Image size 1960x1897, 45° field of view
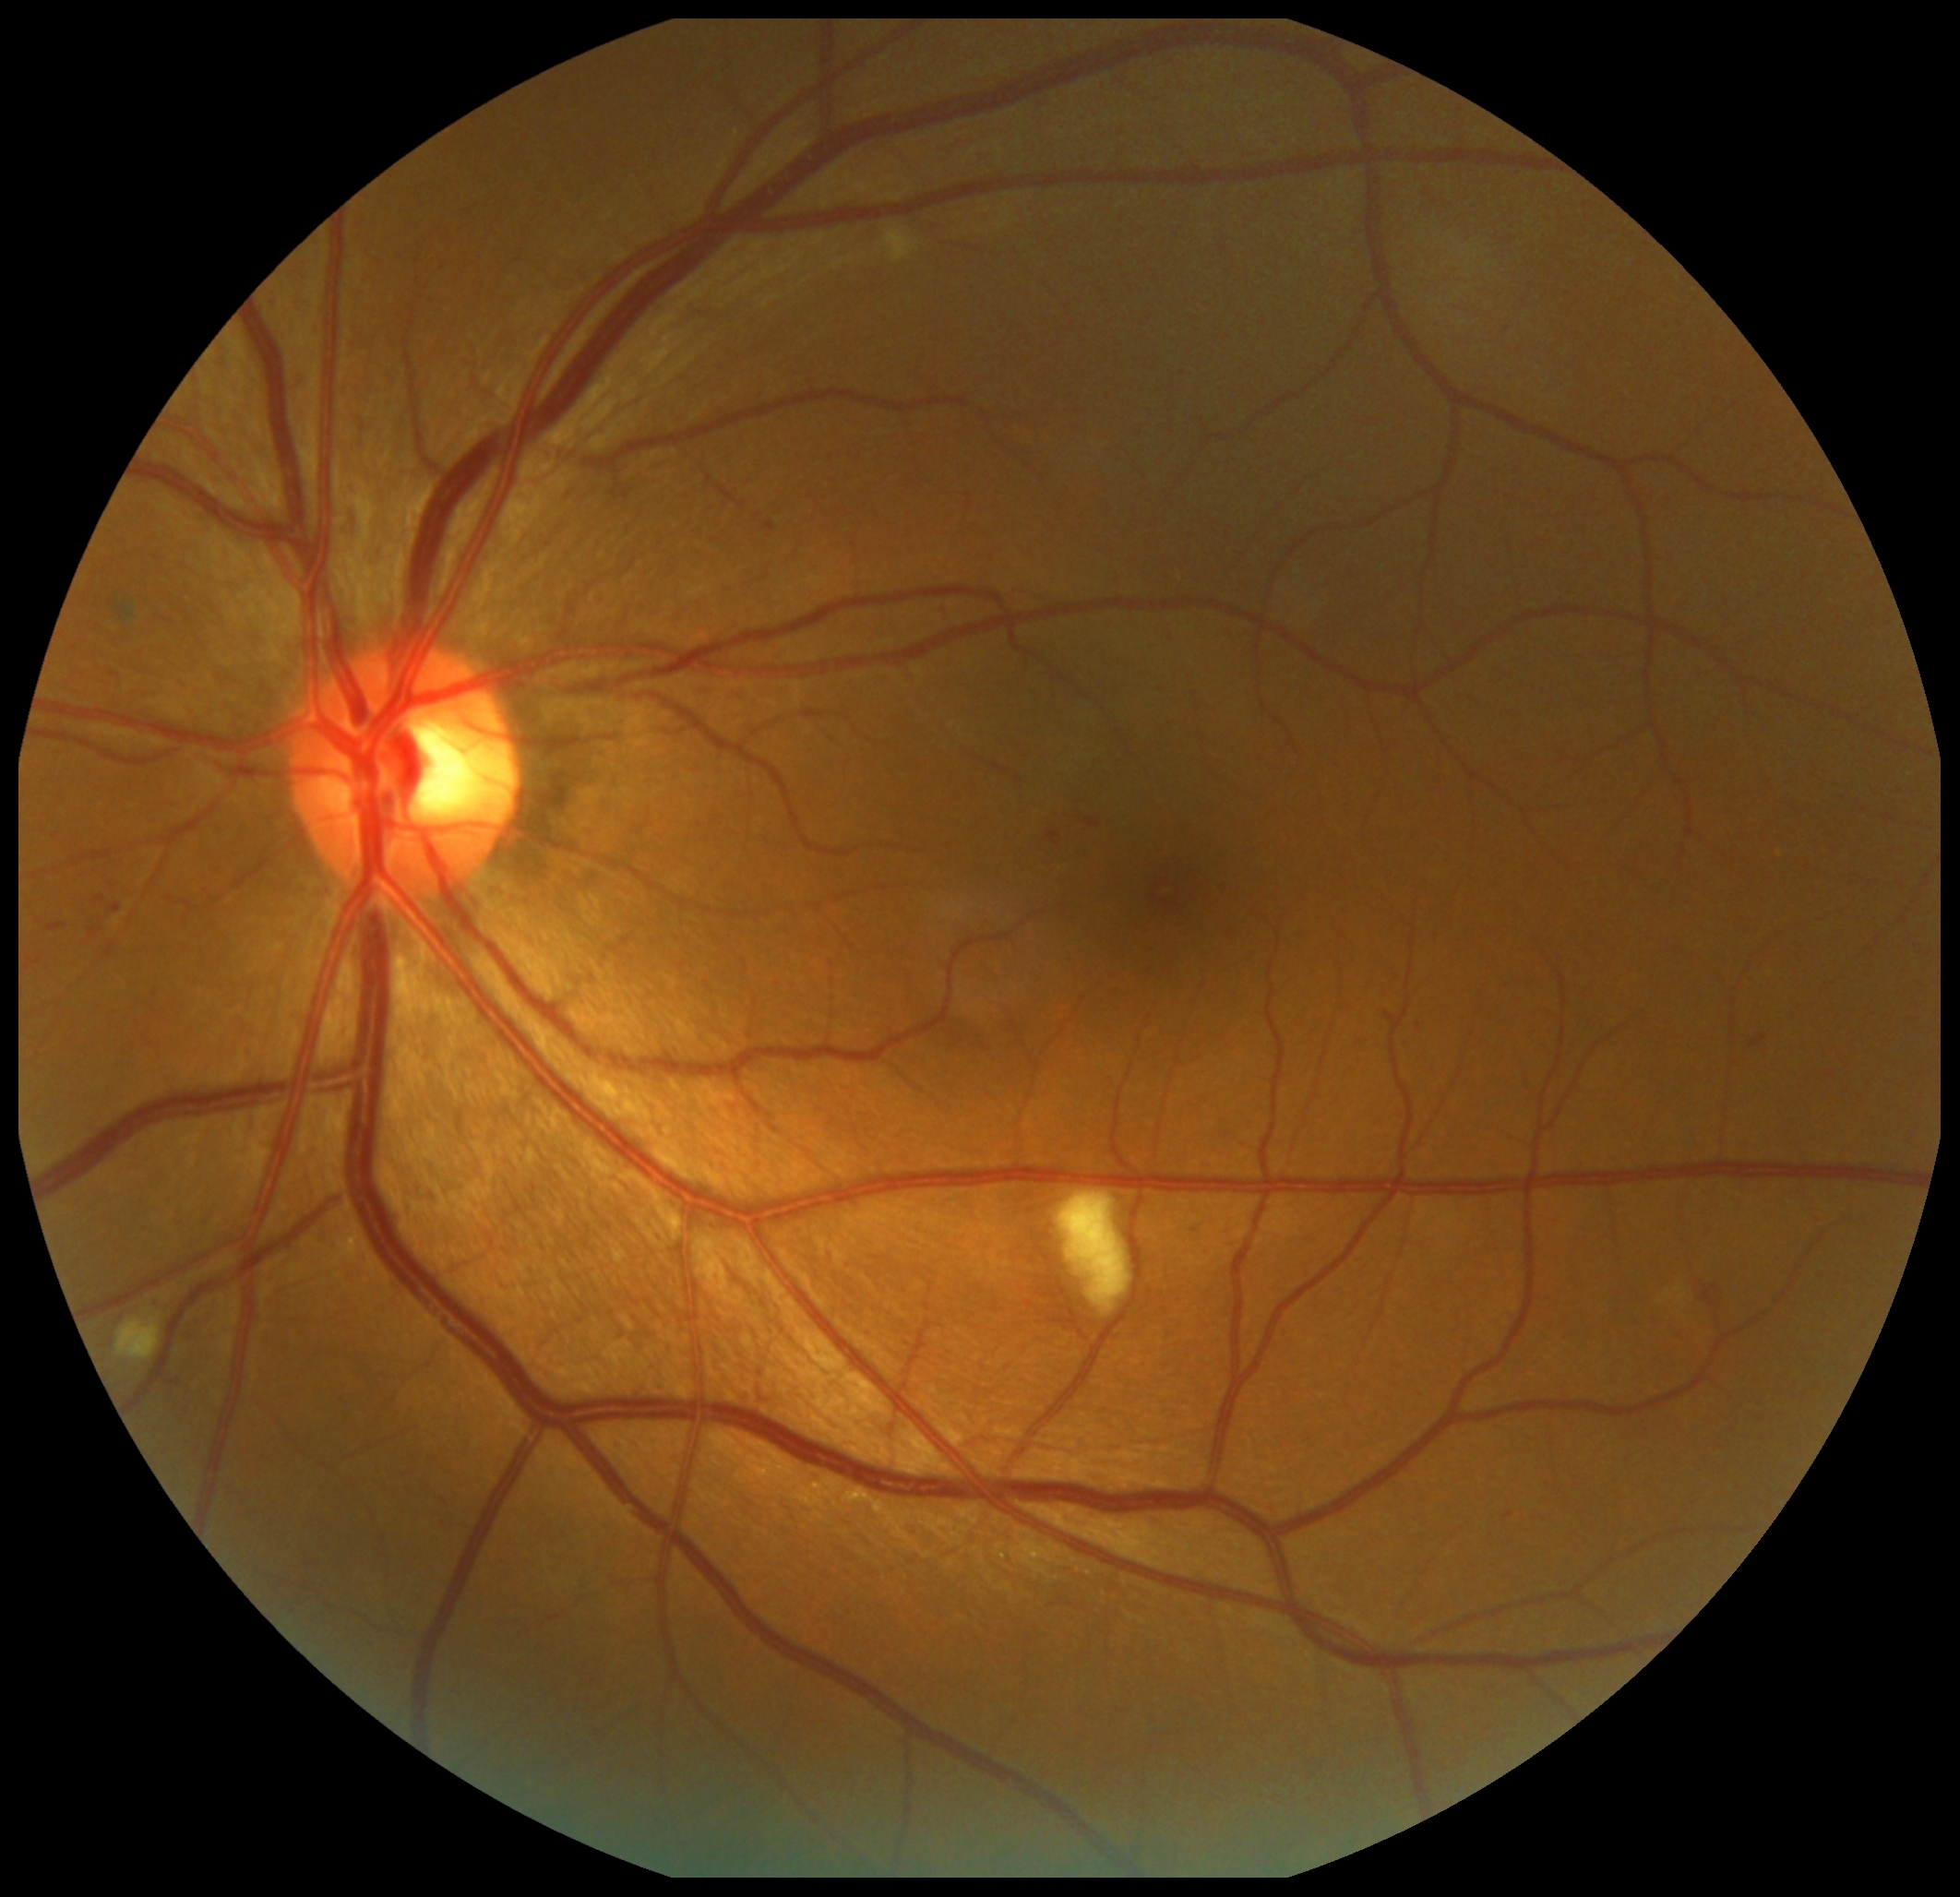

Diabetic retinopathy grade is 2/4.